Color fundus photograph; 240 x 240 pixels; captured on a Nidek AFC-330 fundus camera — 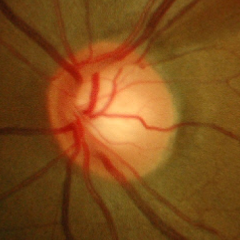
Glaucomatous changes are present. Glaucoma status = early-stage glaucoma.